45-degree field of view, retinal fundus photograph: 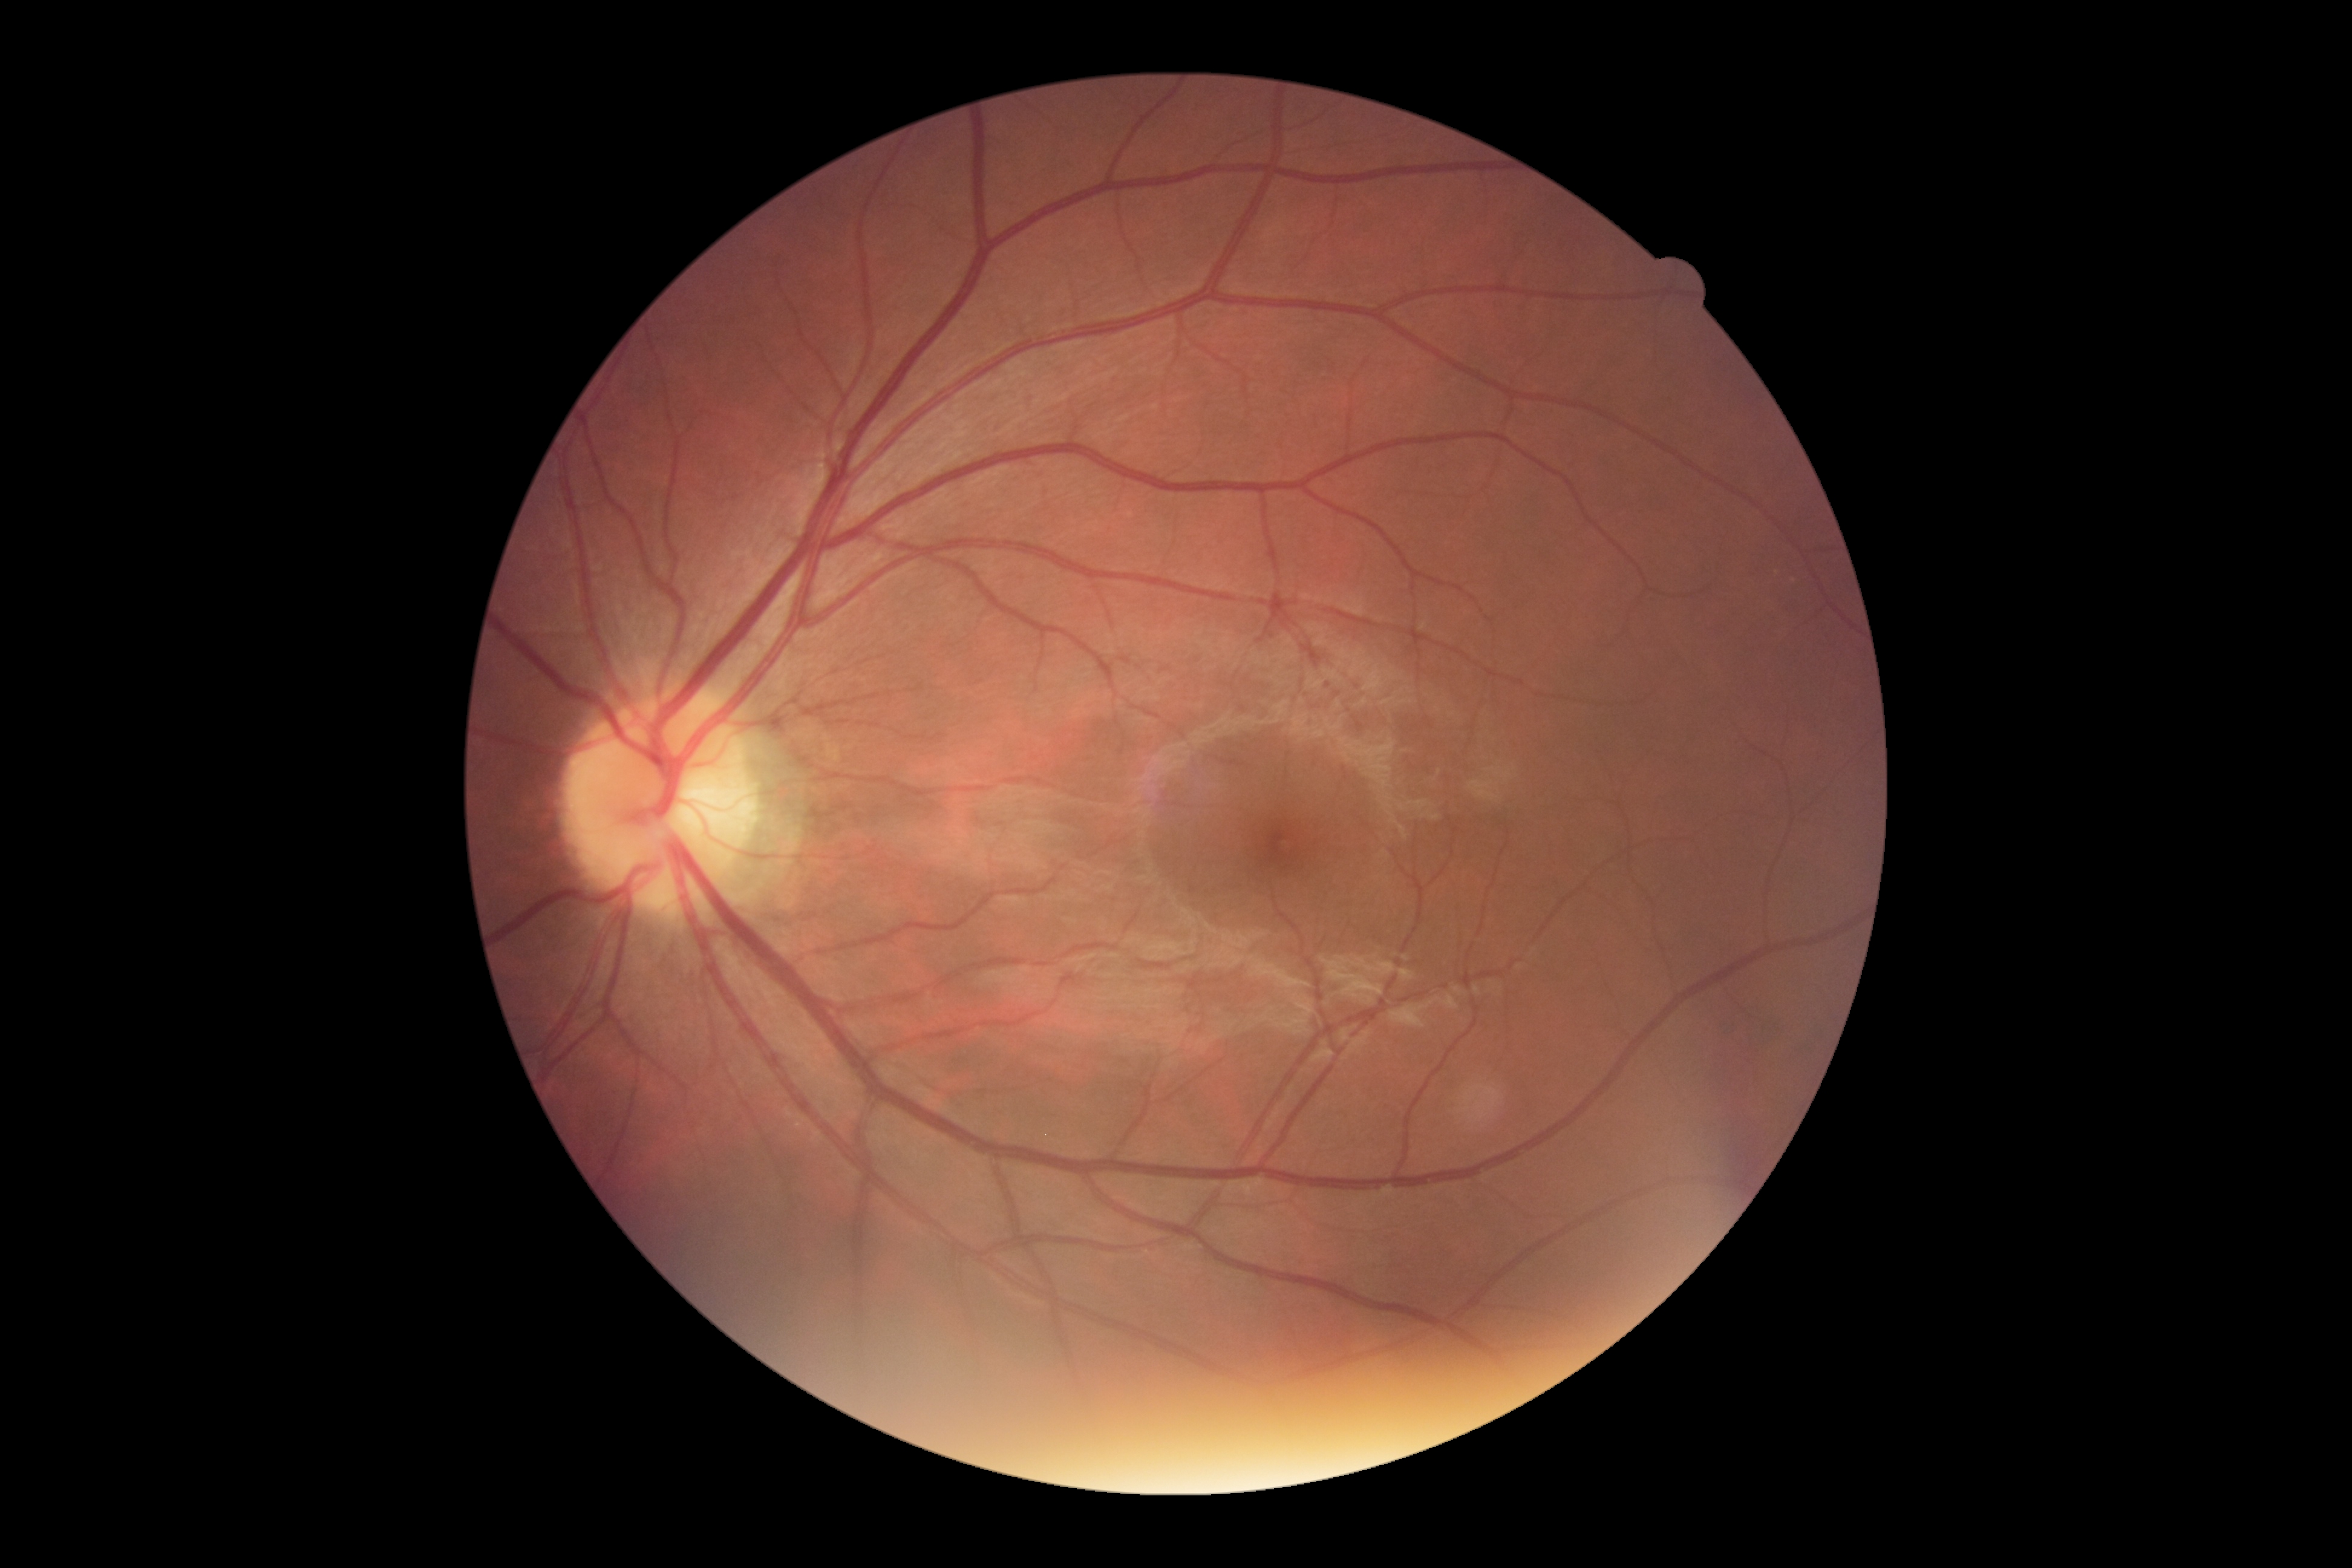 retinopathy grade: no apparent diabetic retinopathy (0).